Acquired on the Phoenix ICON · wide-field fundus image from infant ROP screening:
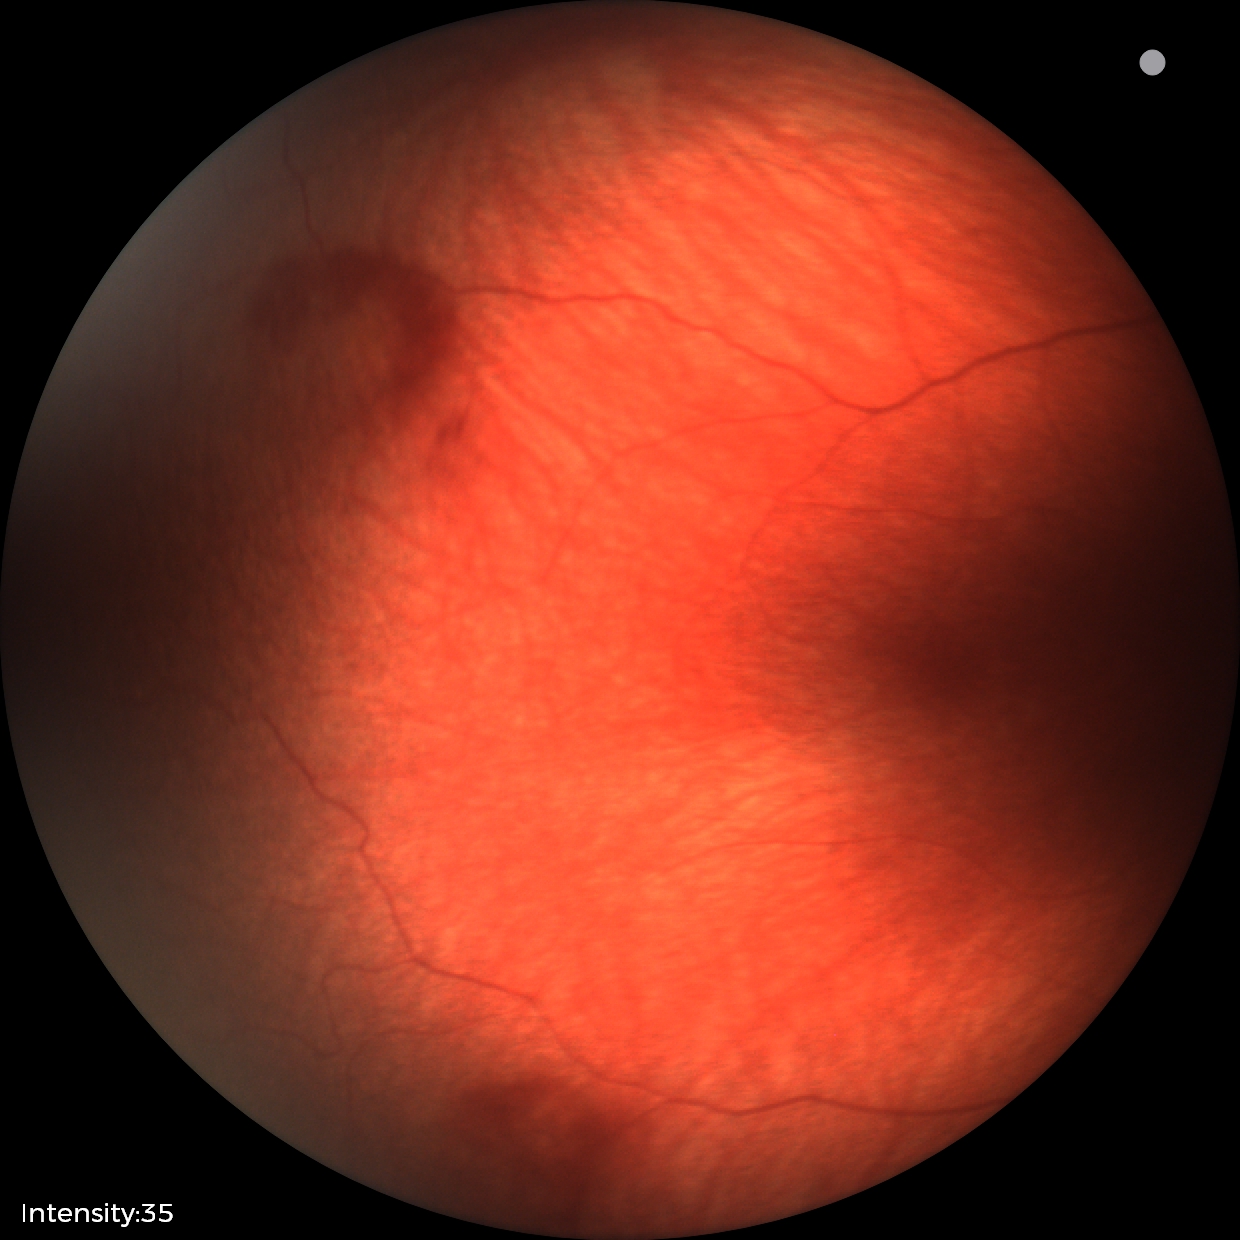
Impression: retinal hemorrhages.